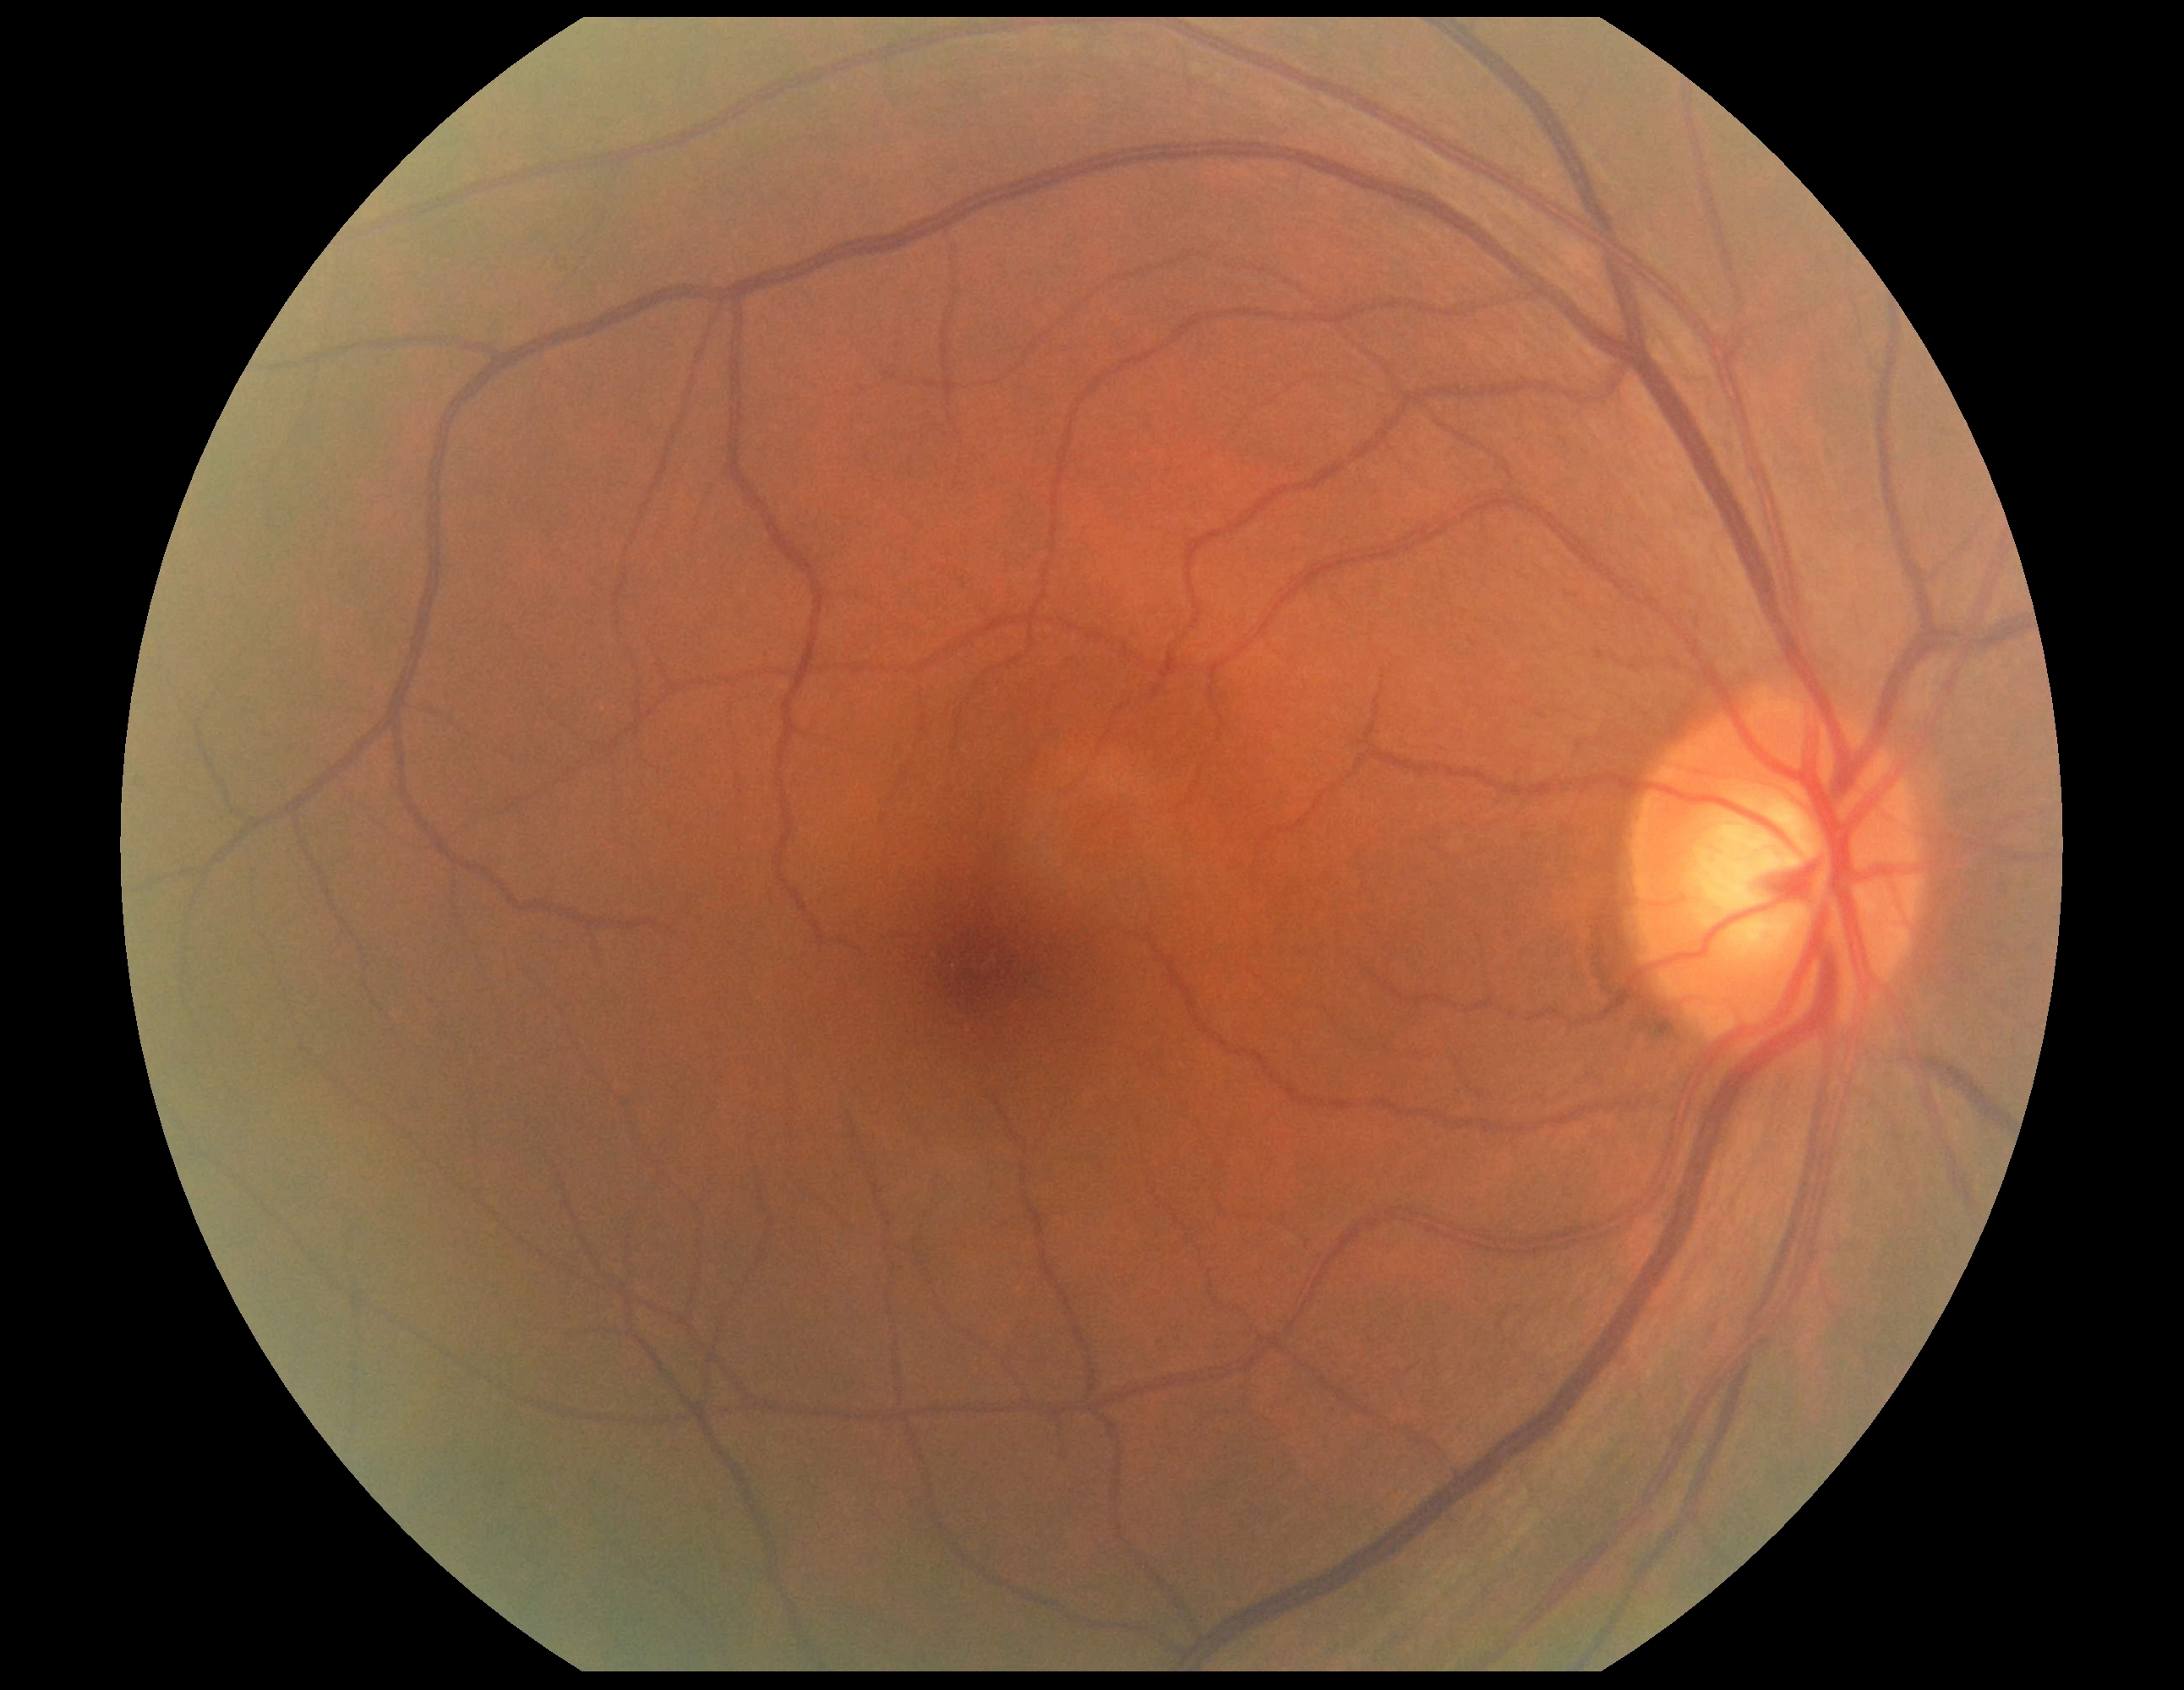

{"dr_grade": "0 (no apparent retinopathy)"}